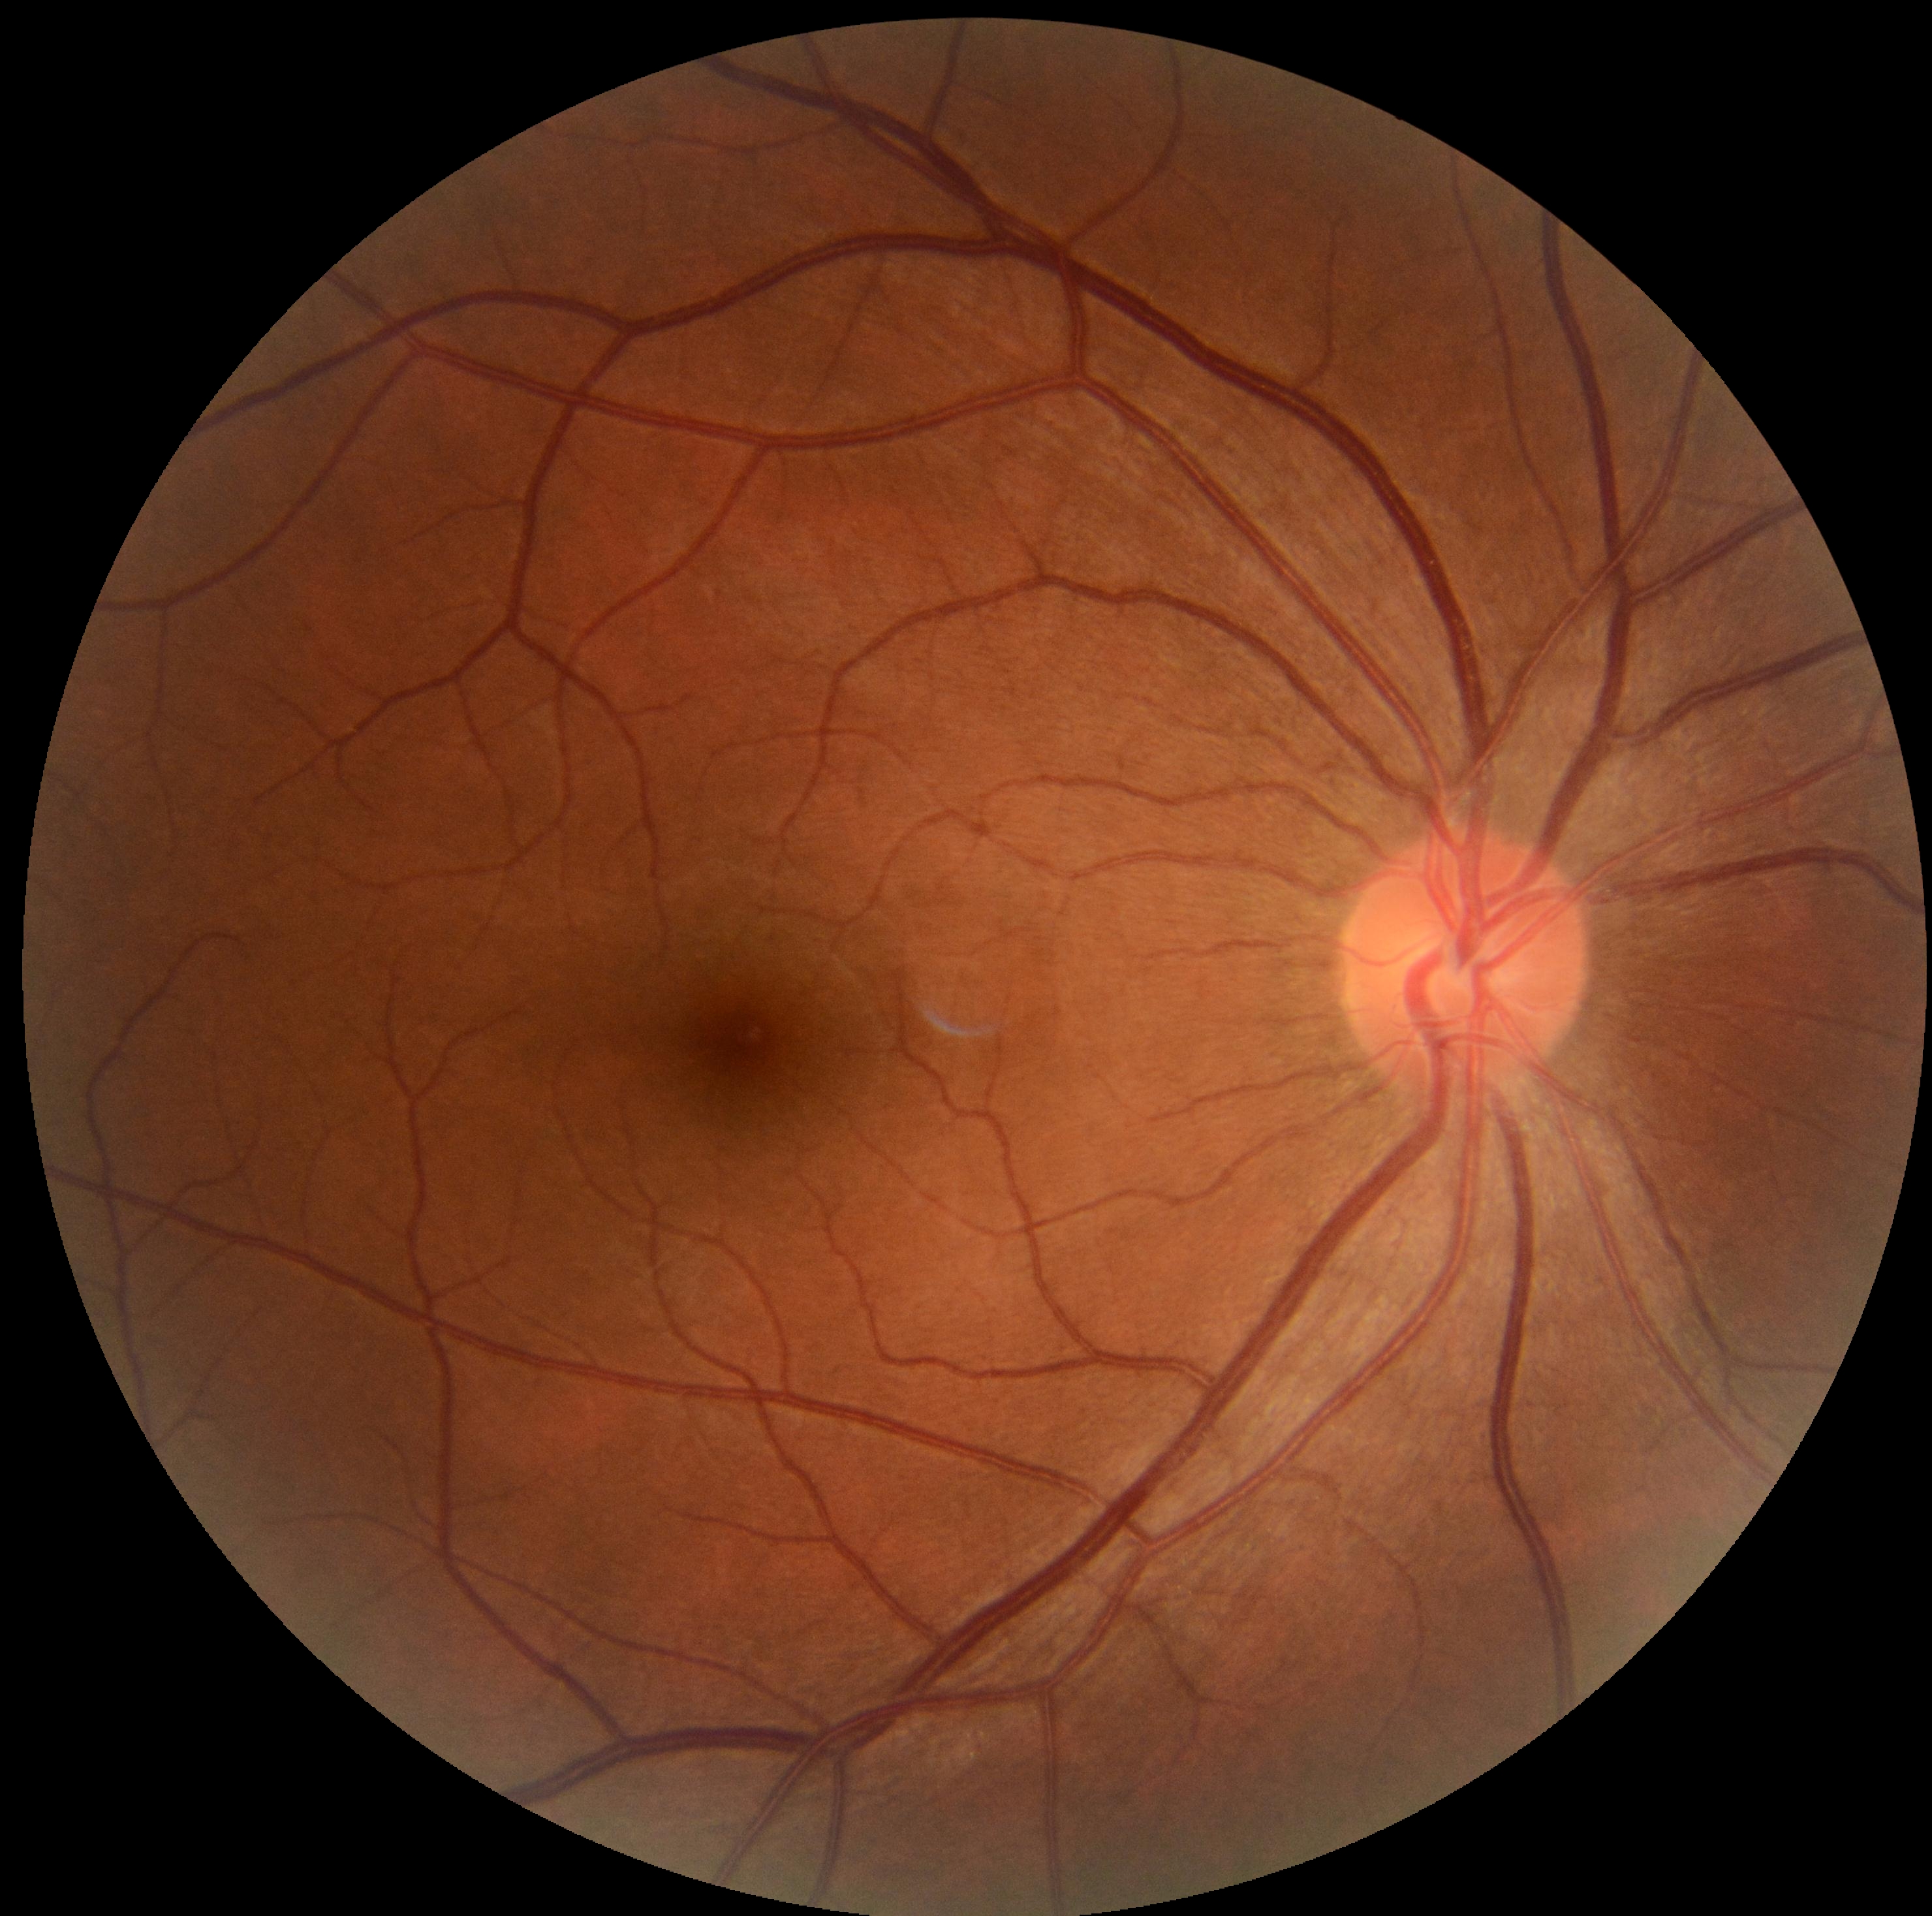 – DR: no apparent diabetic retinopathy (grade 0)